2352 by 1568 pixels · color fundus photograph · FOV: 45 degrees: 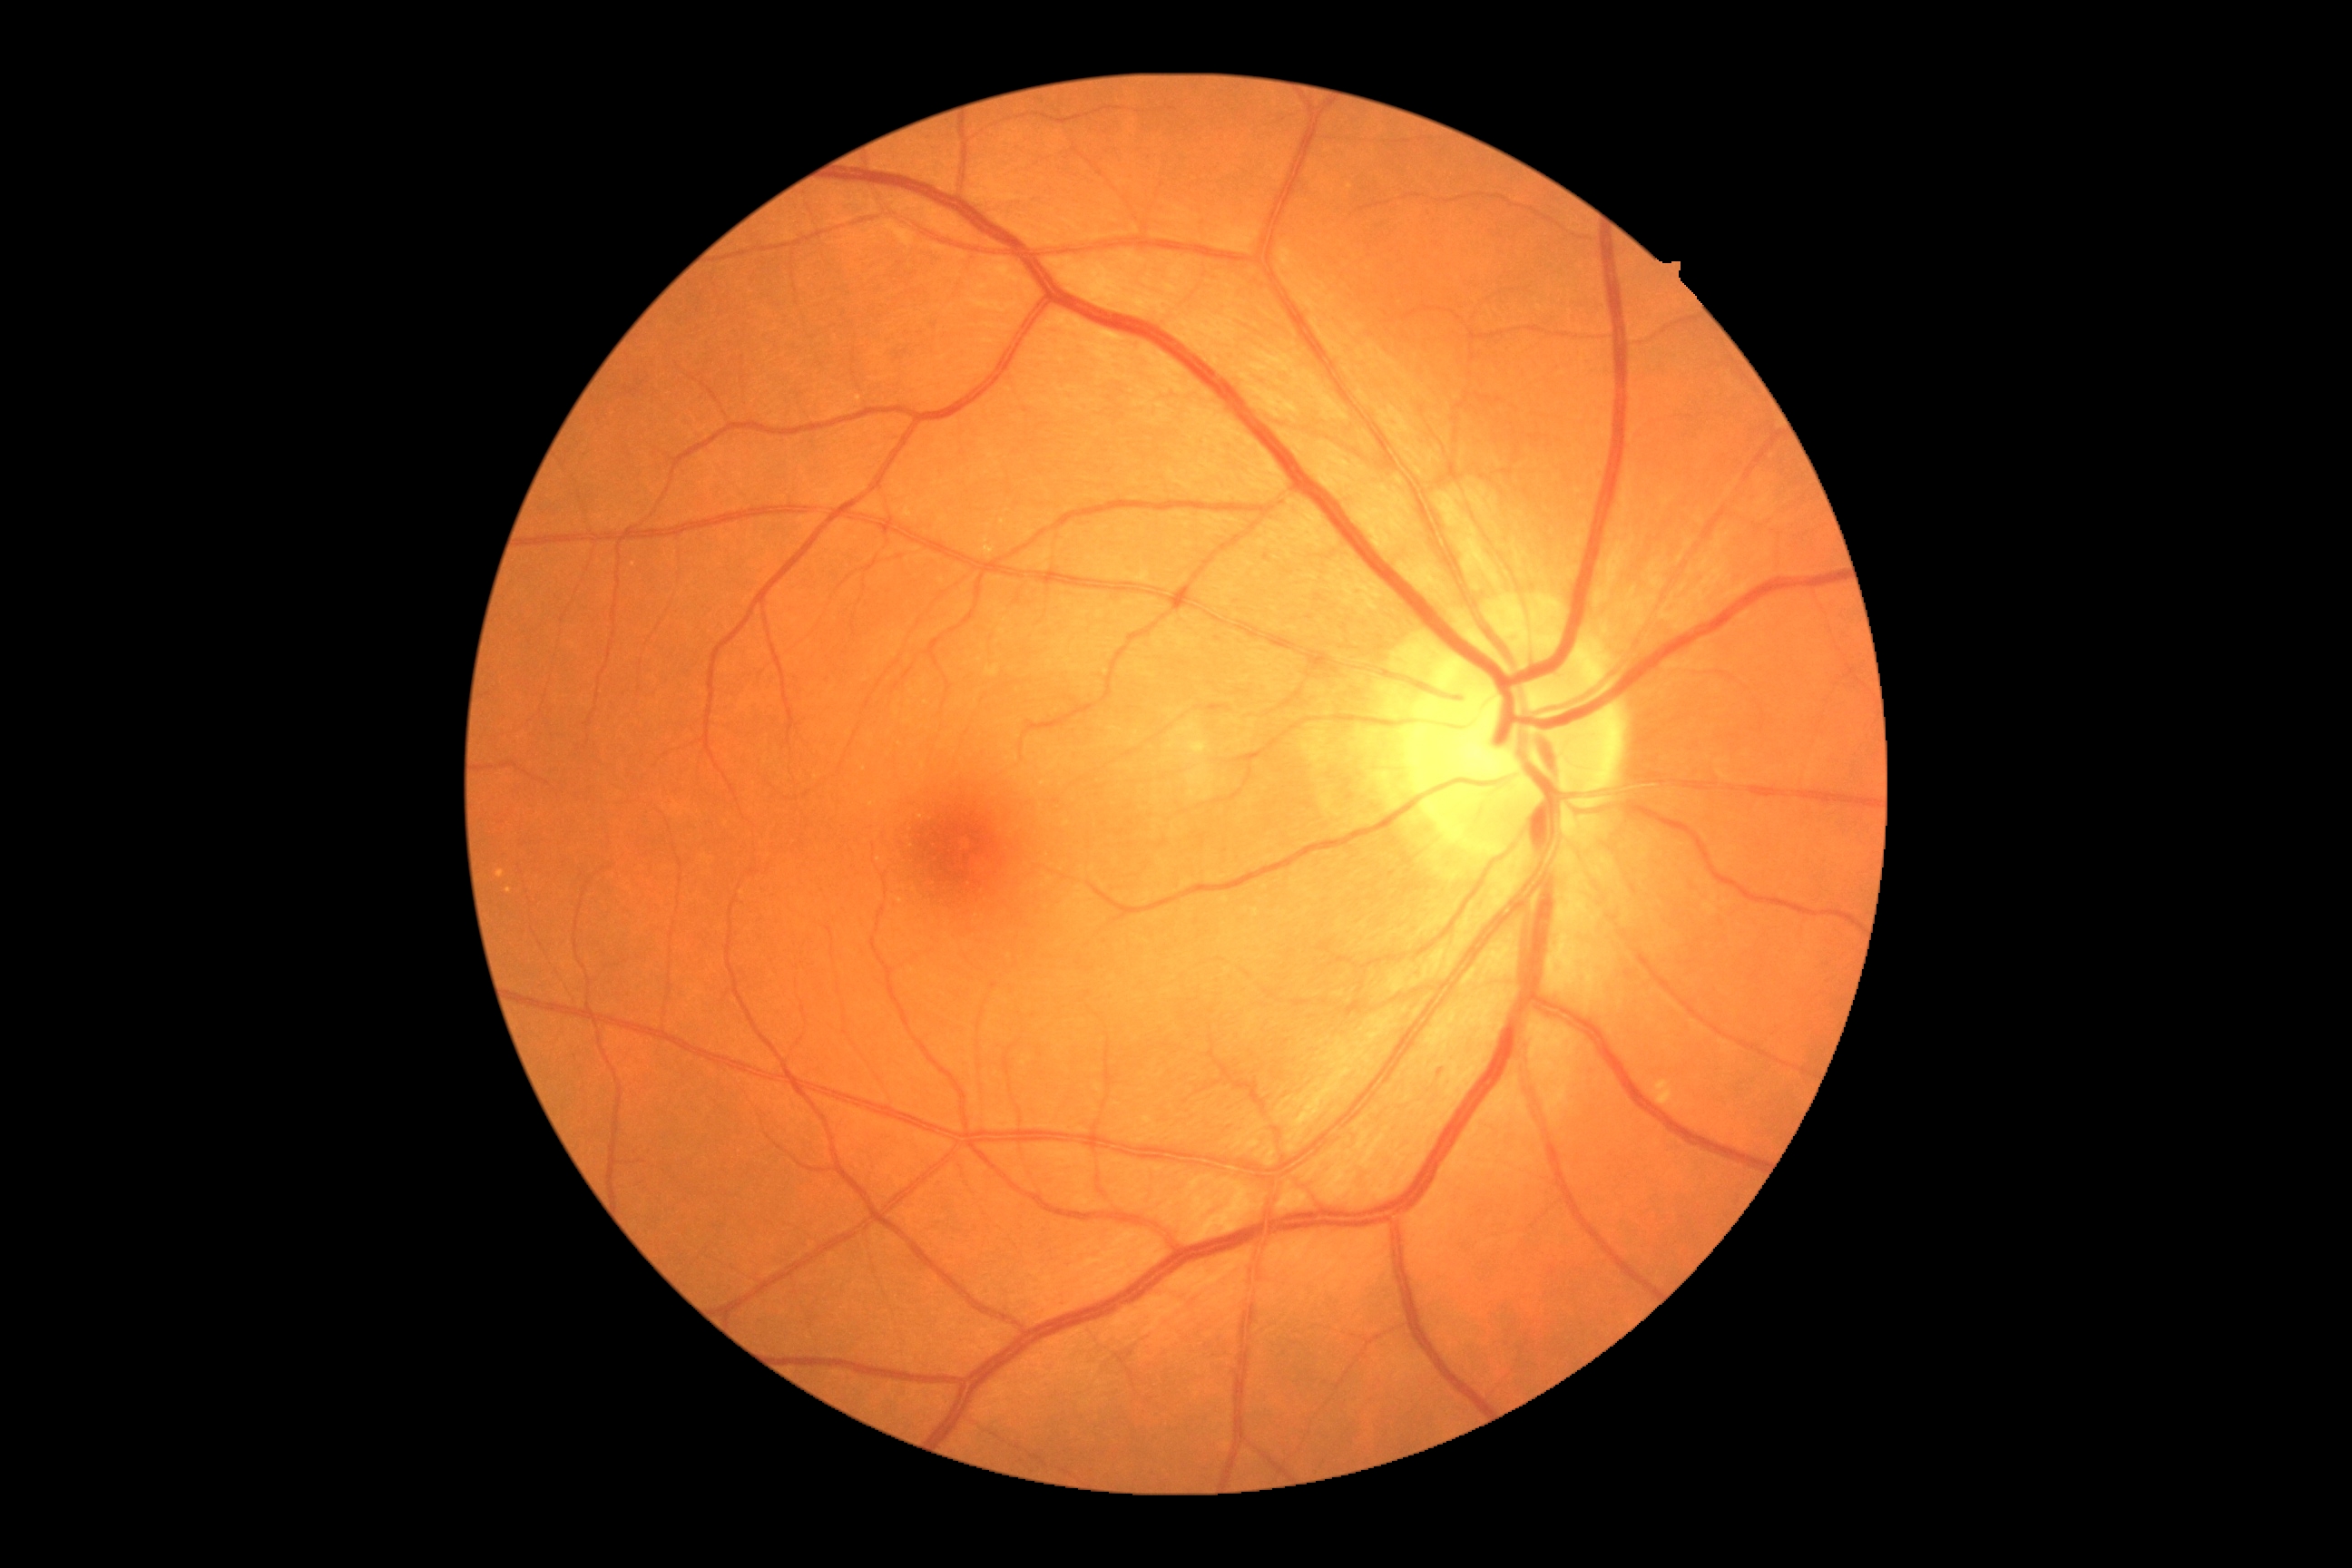 Diabetic retinopathy (DR): 0/4.